Wide-field retinal mosaic image: 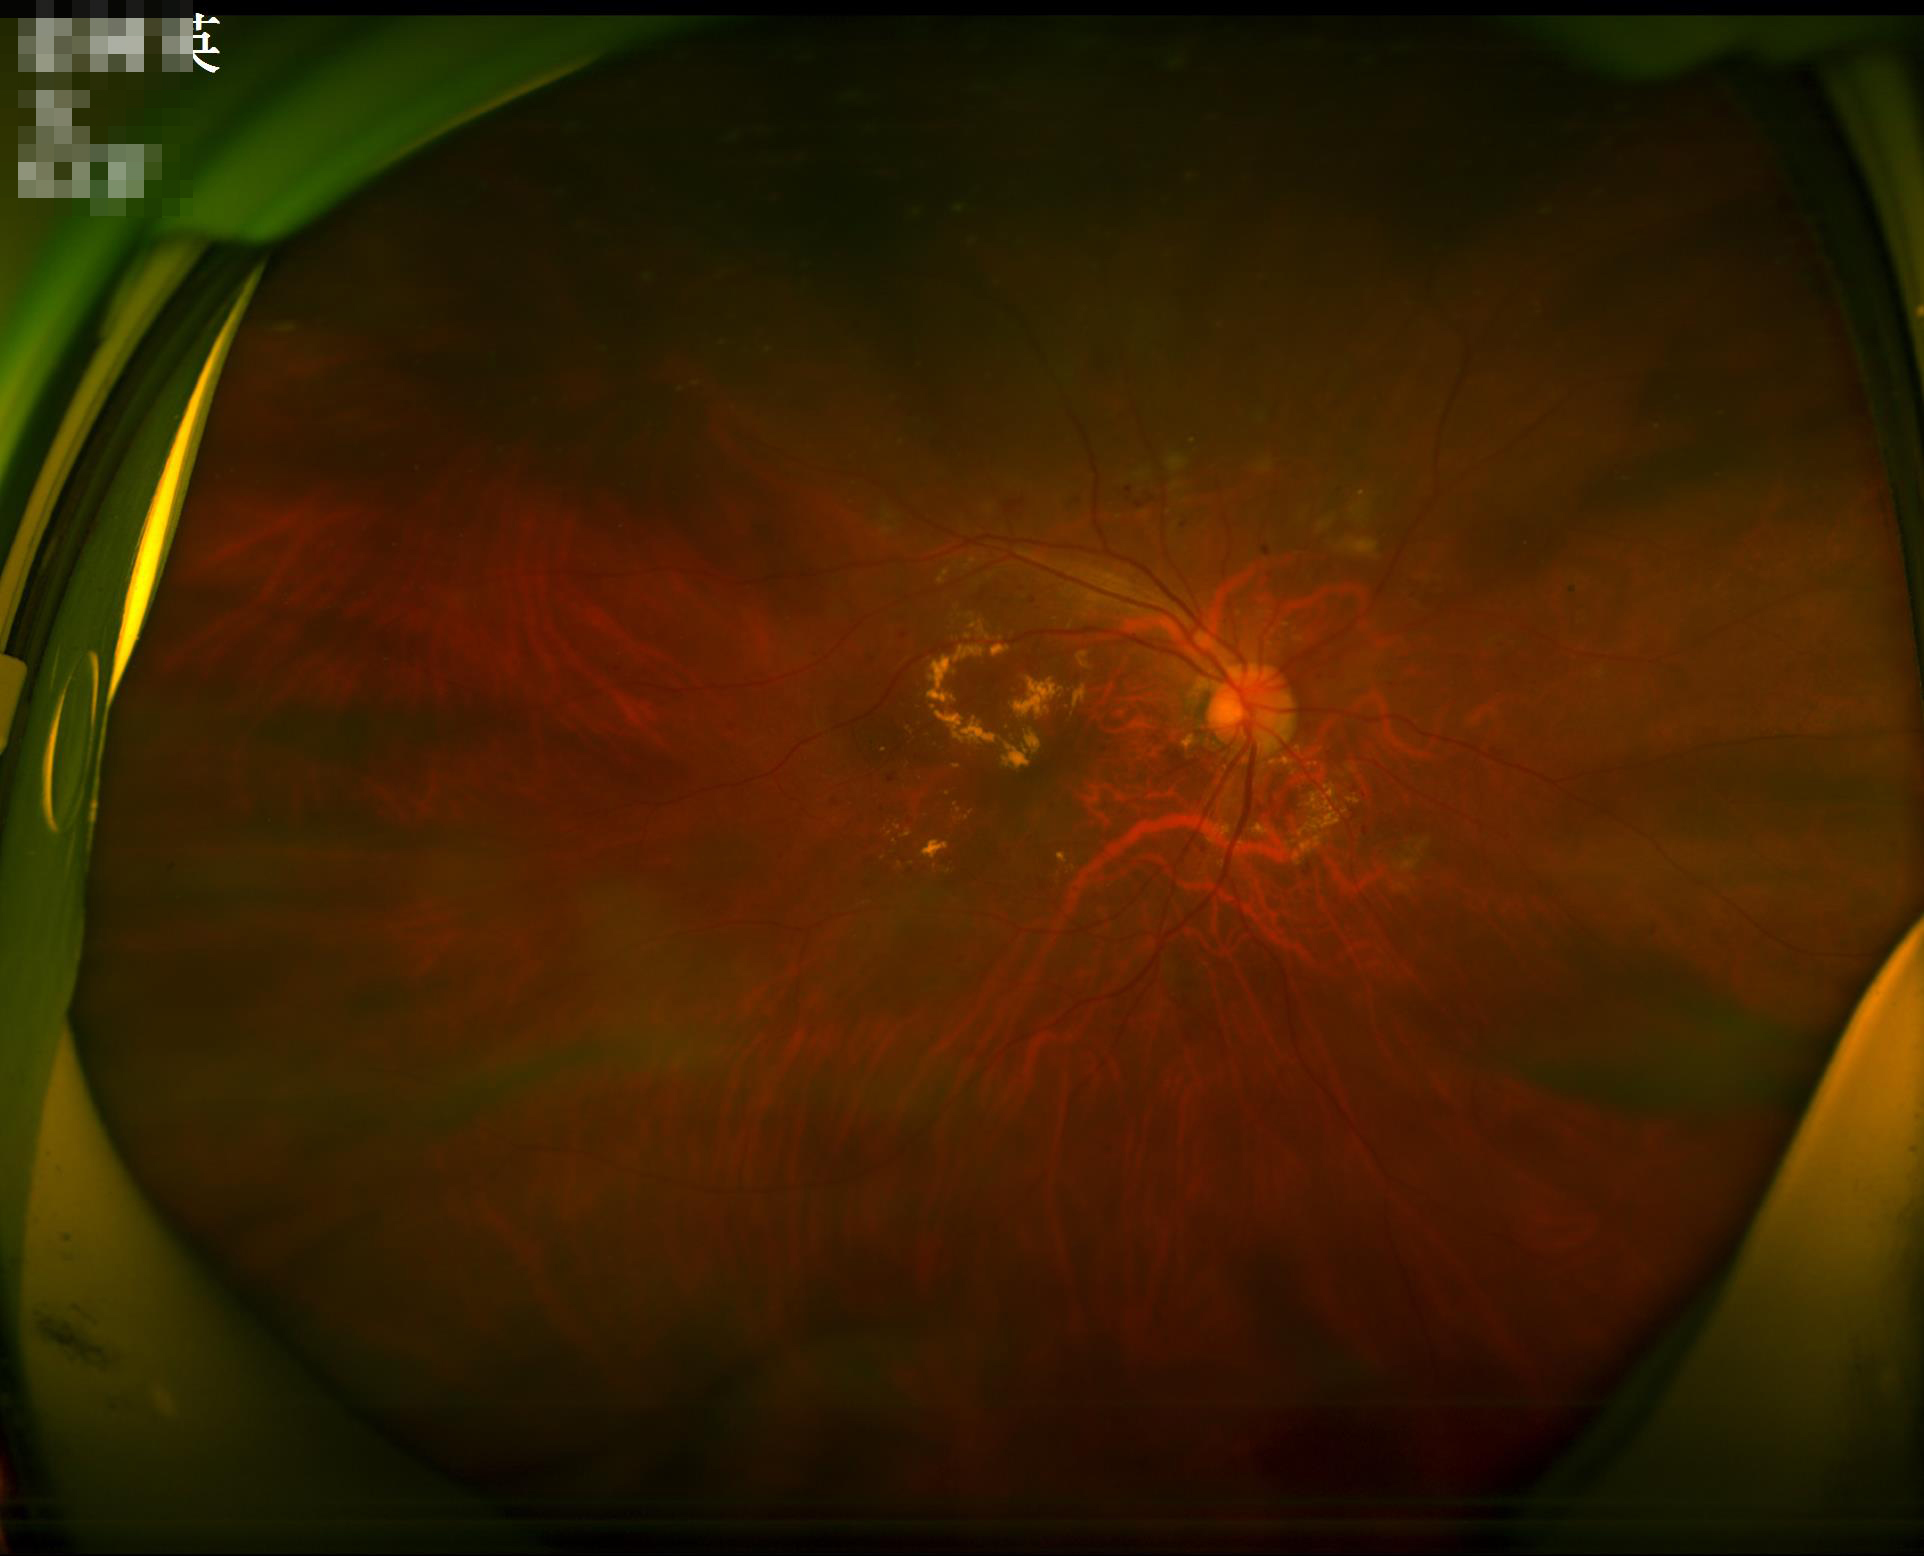

Focus = out of focus
Overall quality = inadequate
Illumination = poor
Contrast = good